NIDEK AFC-230 · DR severity per modified Davis staging
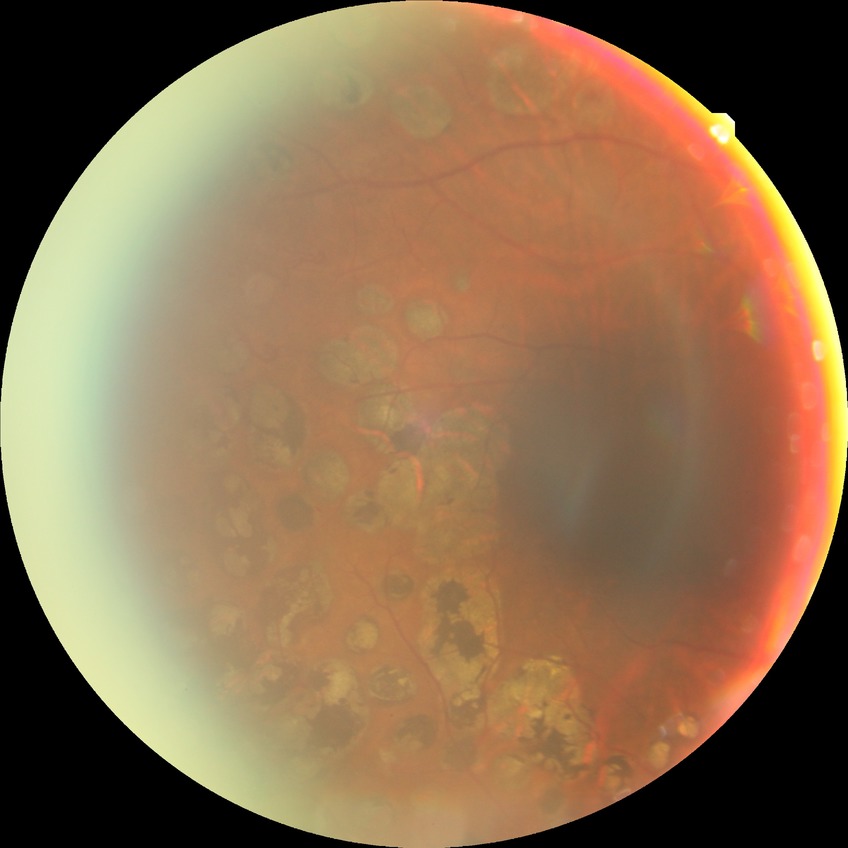

Diabetic retinopathy (DR) is proliferative diabetic retinopathy (PDR).